Pediatric wide-field fundus photograph · 640 by 480 pixels
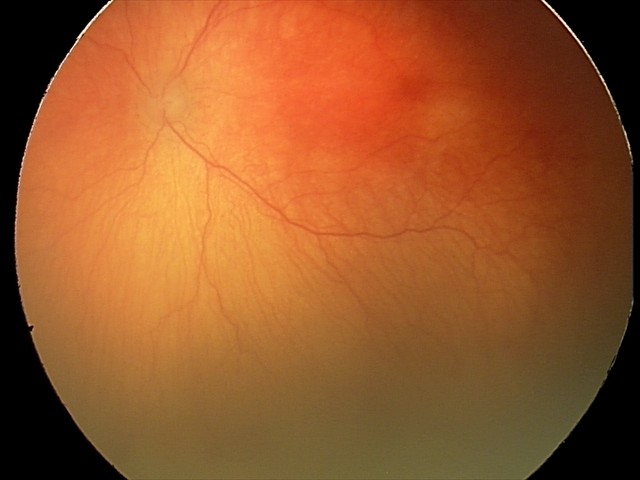
Finding = aggressive ROP (A-ROP) | plus form = present.